2048x1536 · CFP — 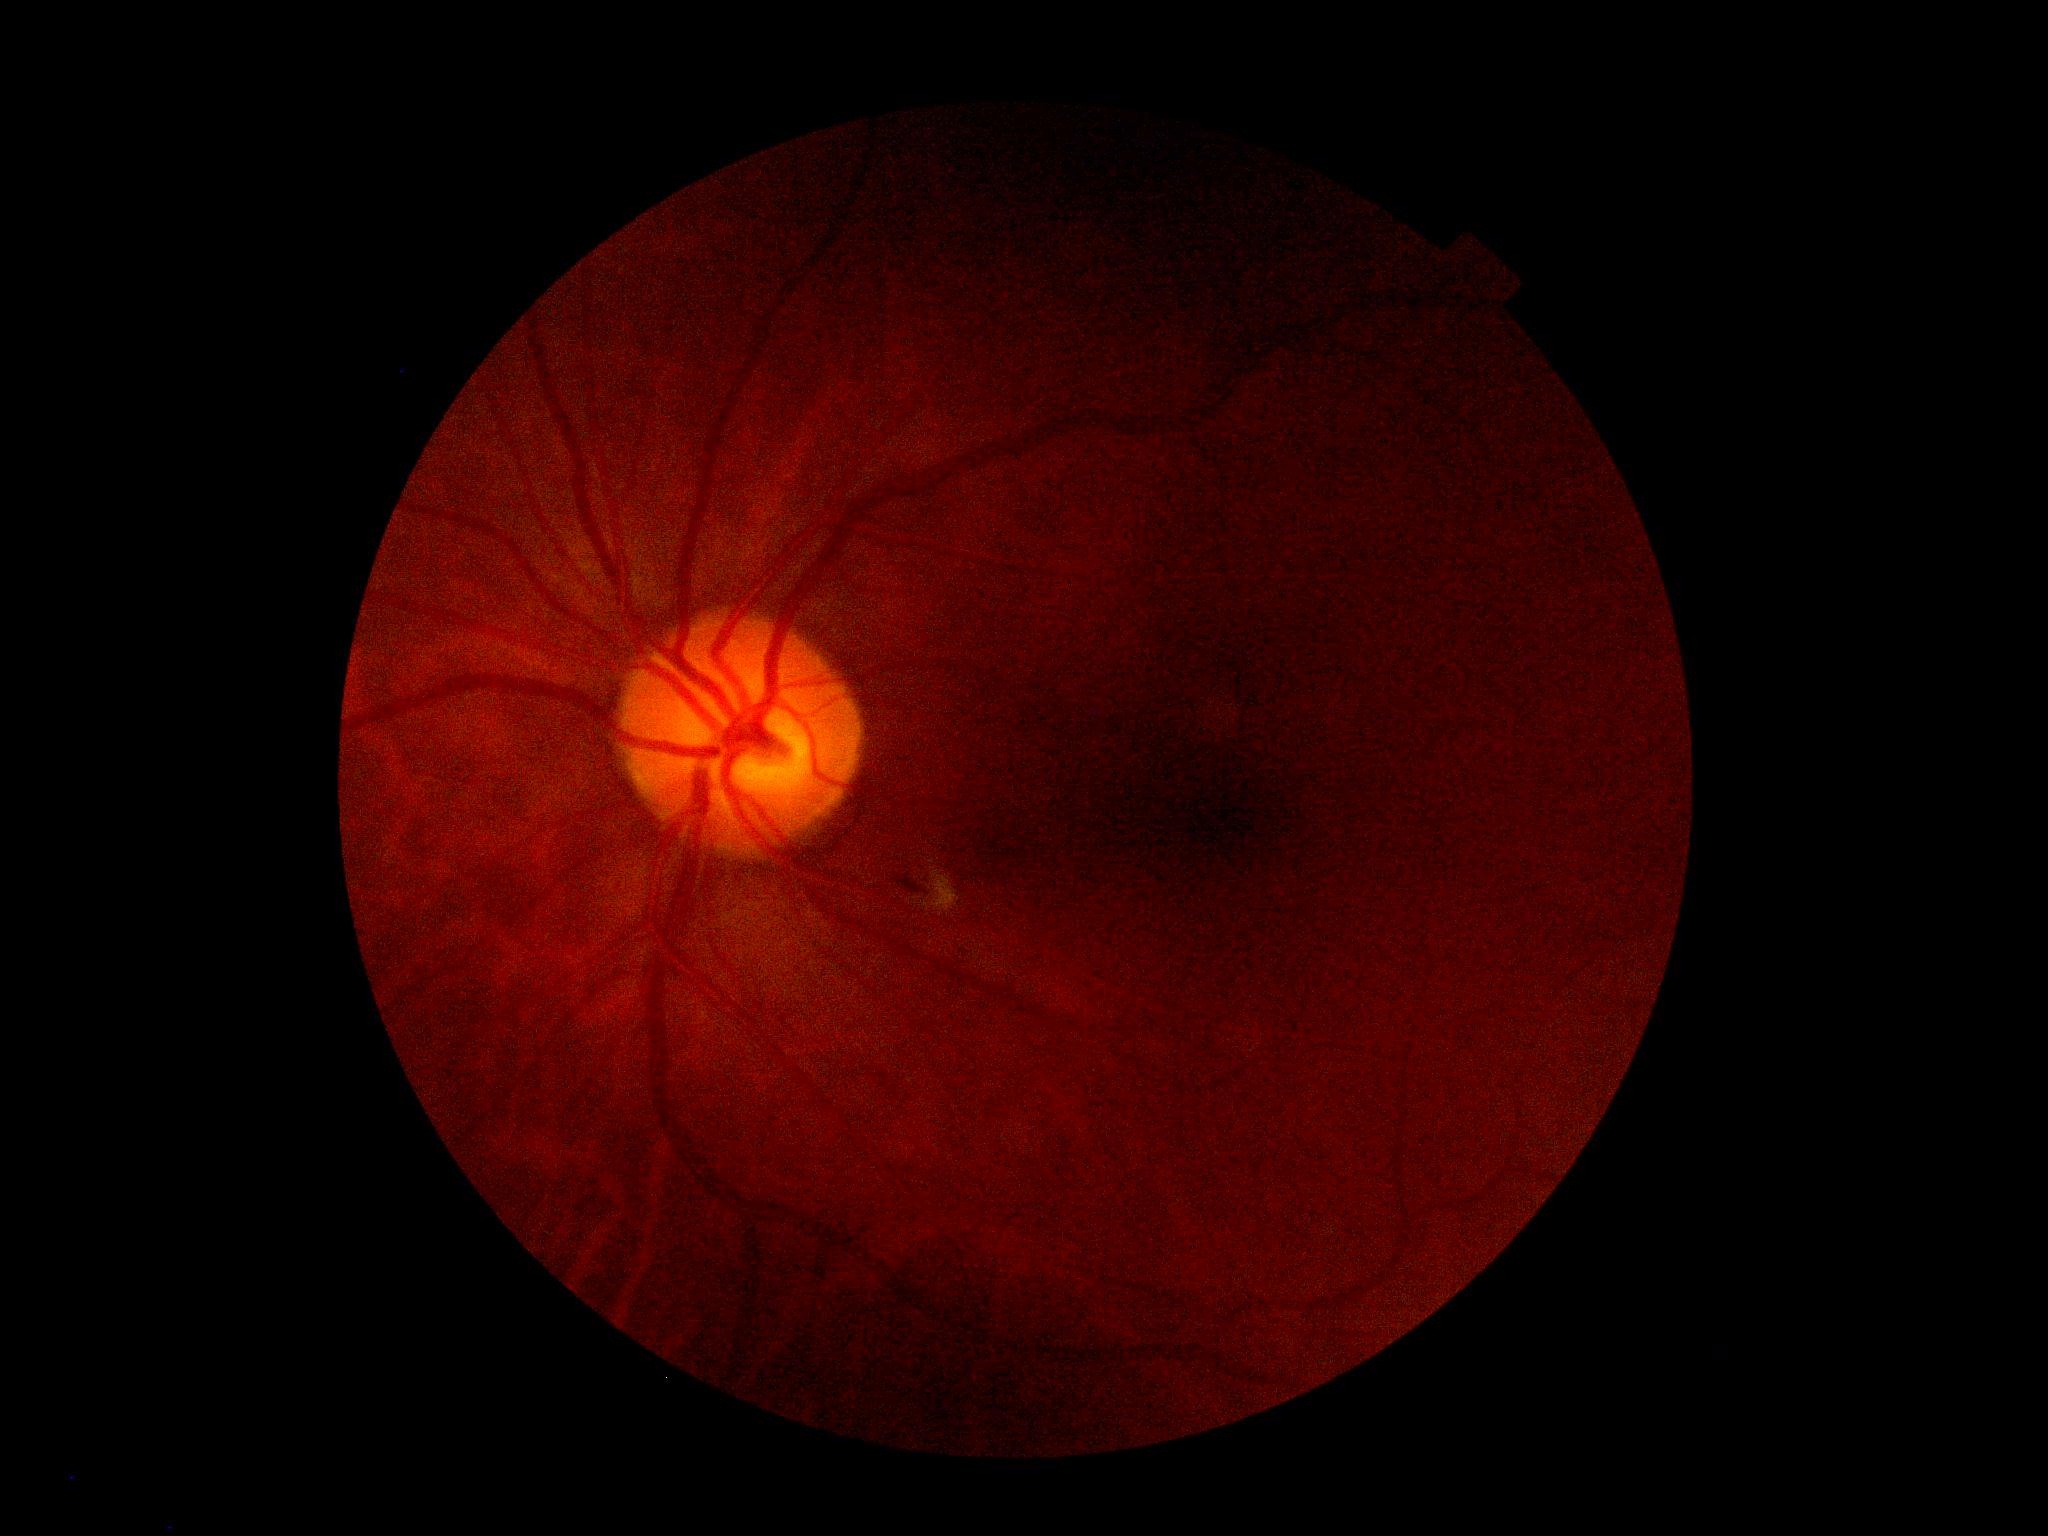

• DR severity — moderate NPDR (grade 2)